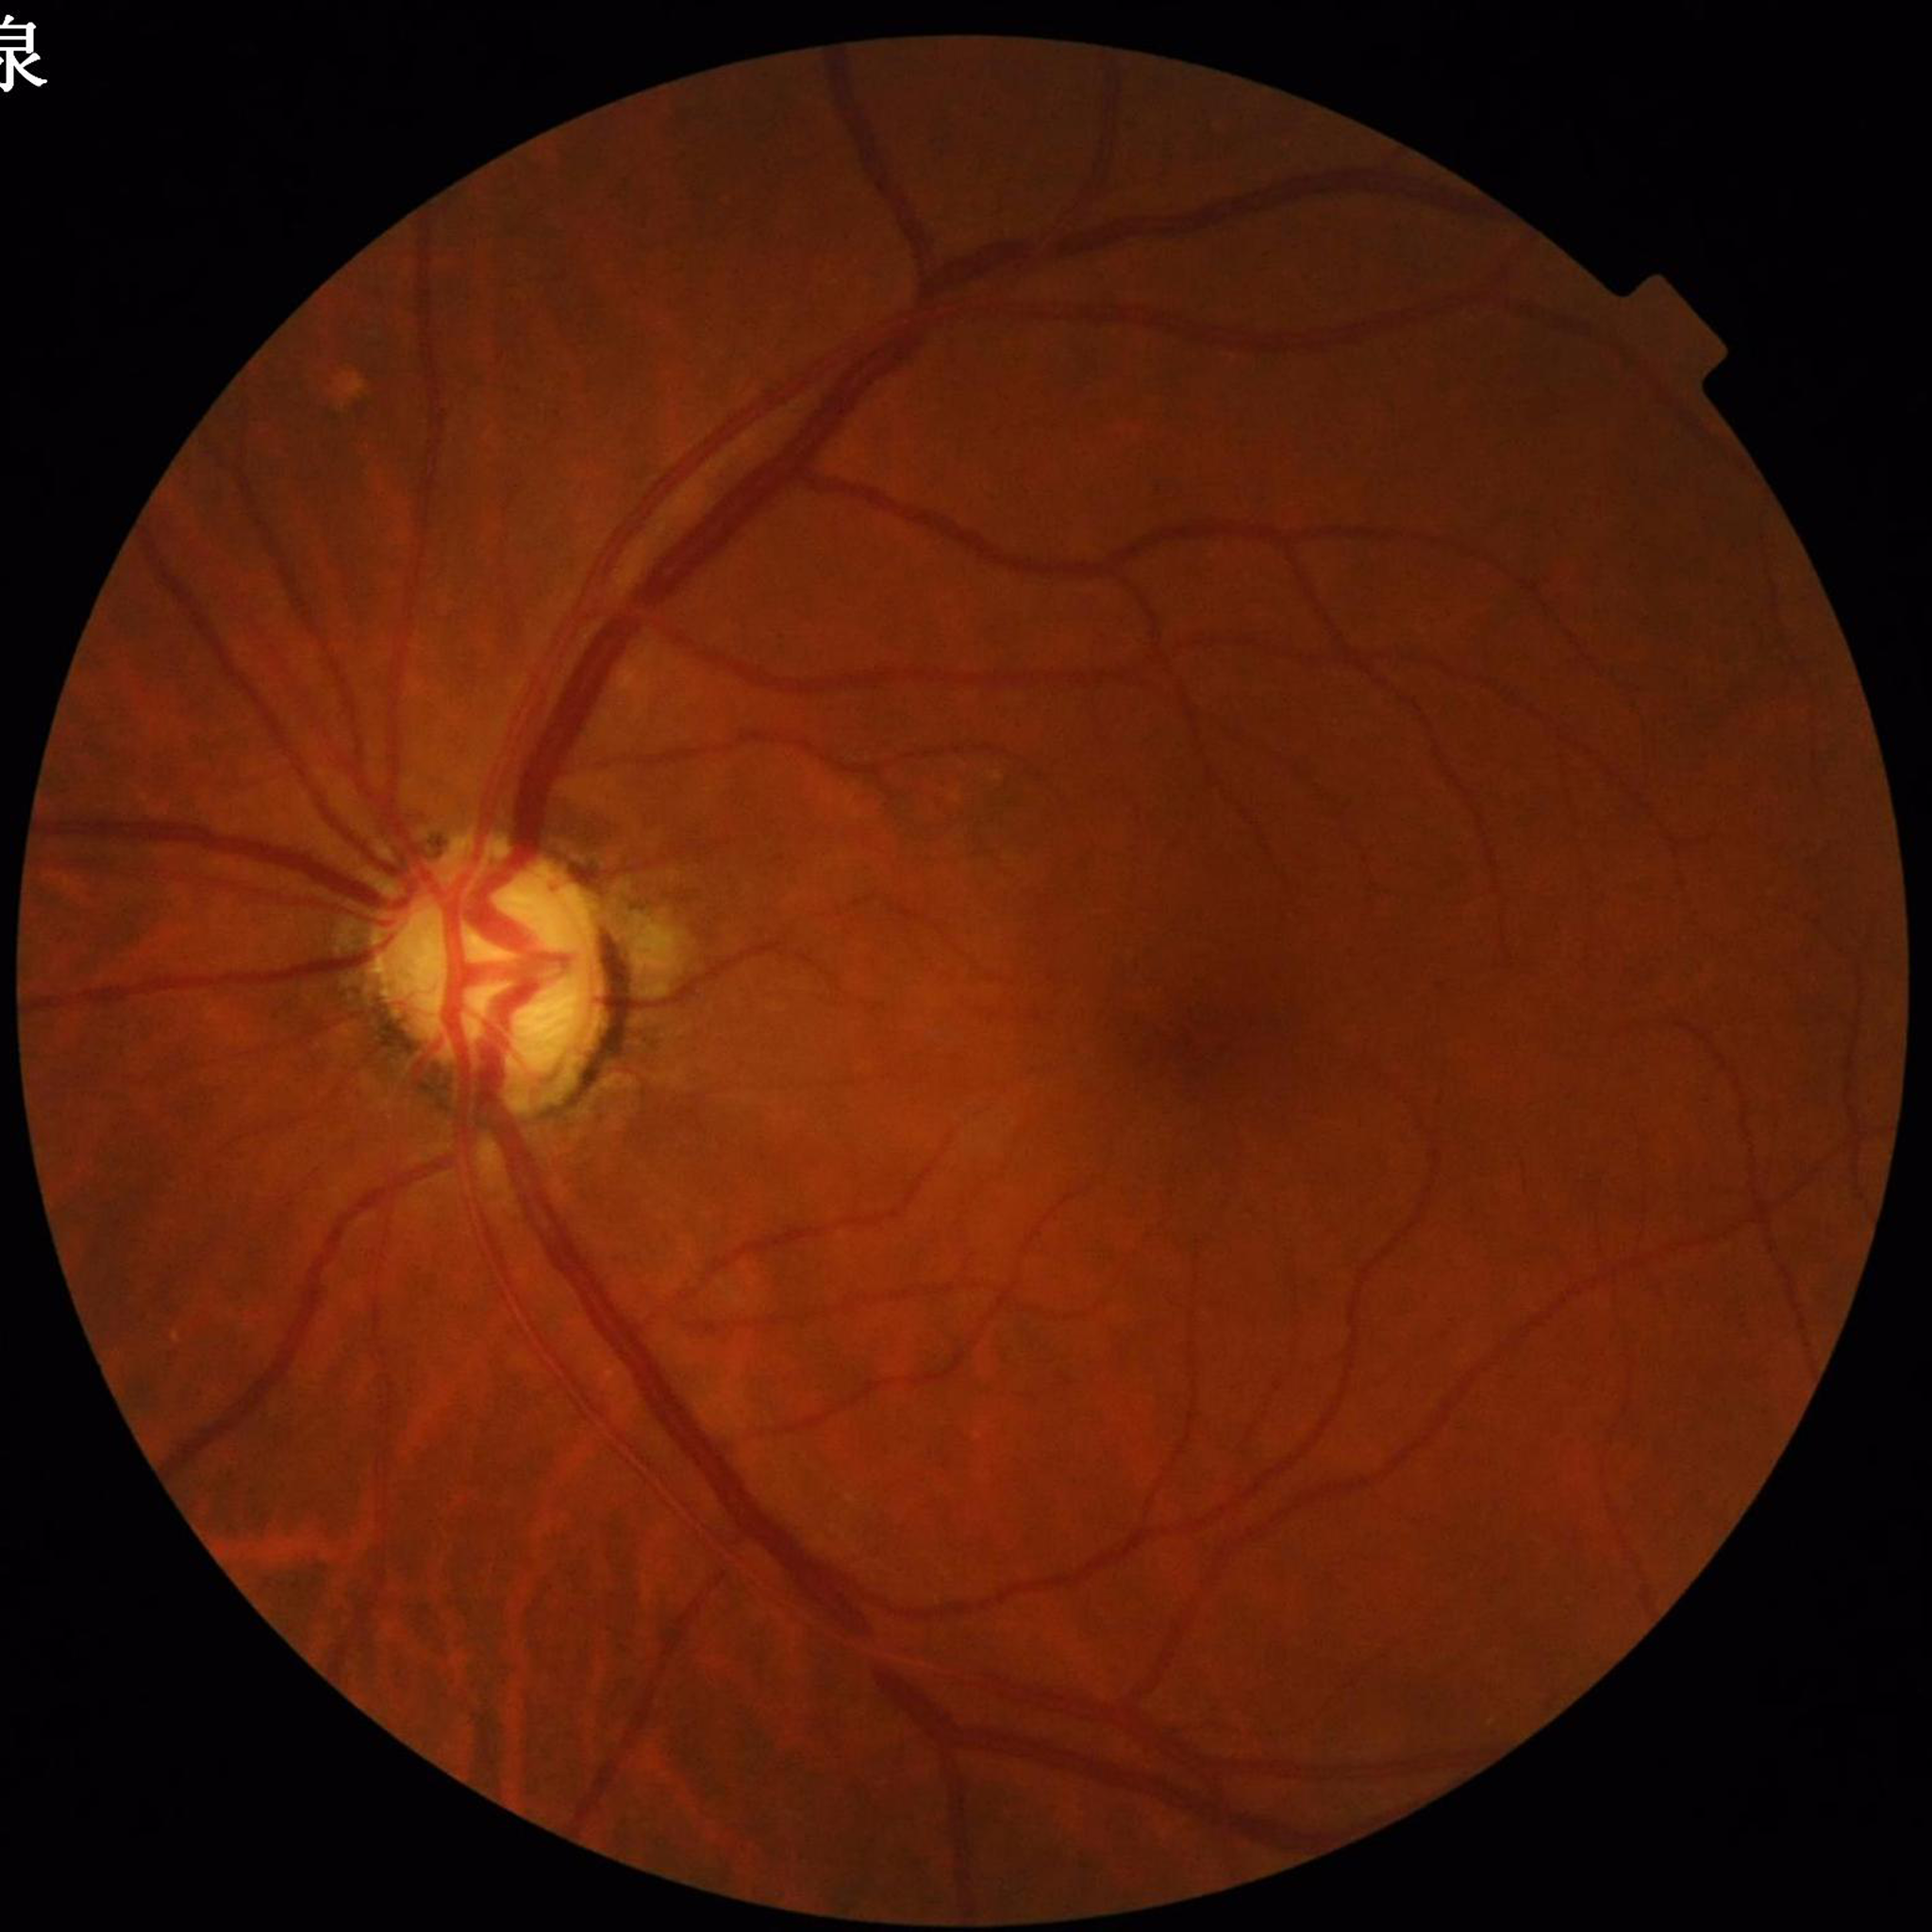 Fundus image of an eye with glaucoma.